Color fundus image; 45° FOV; image size 2352x1568 — 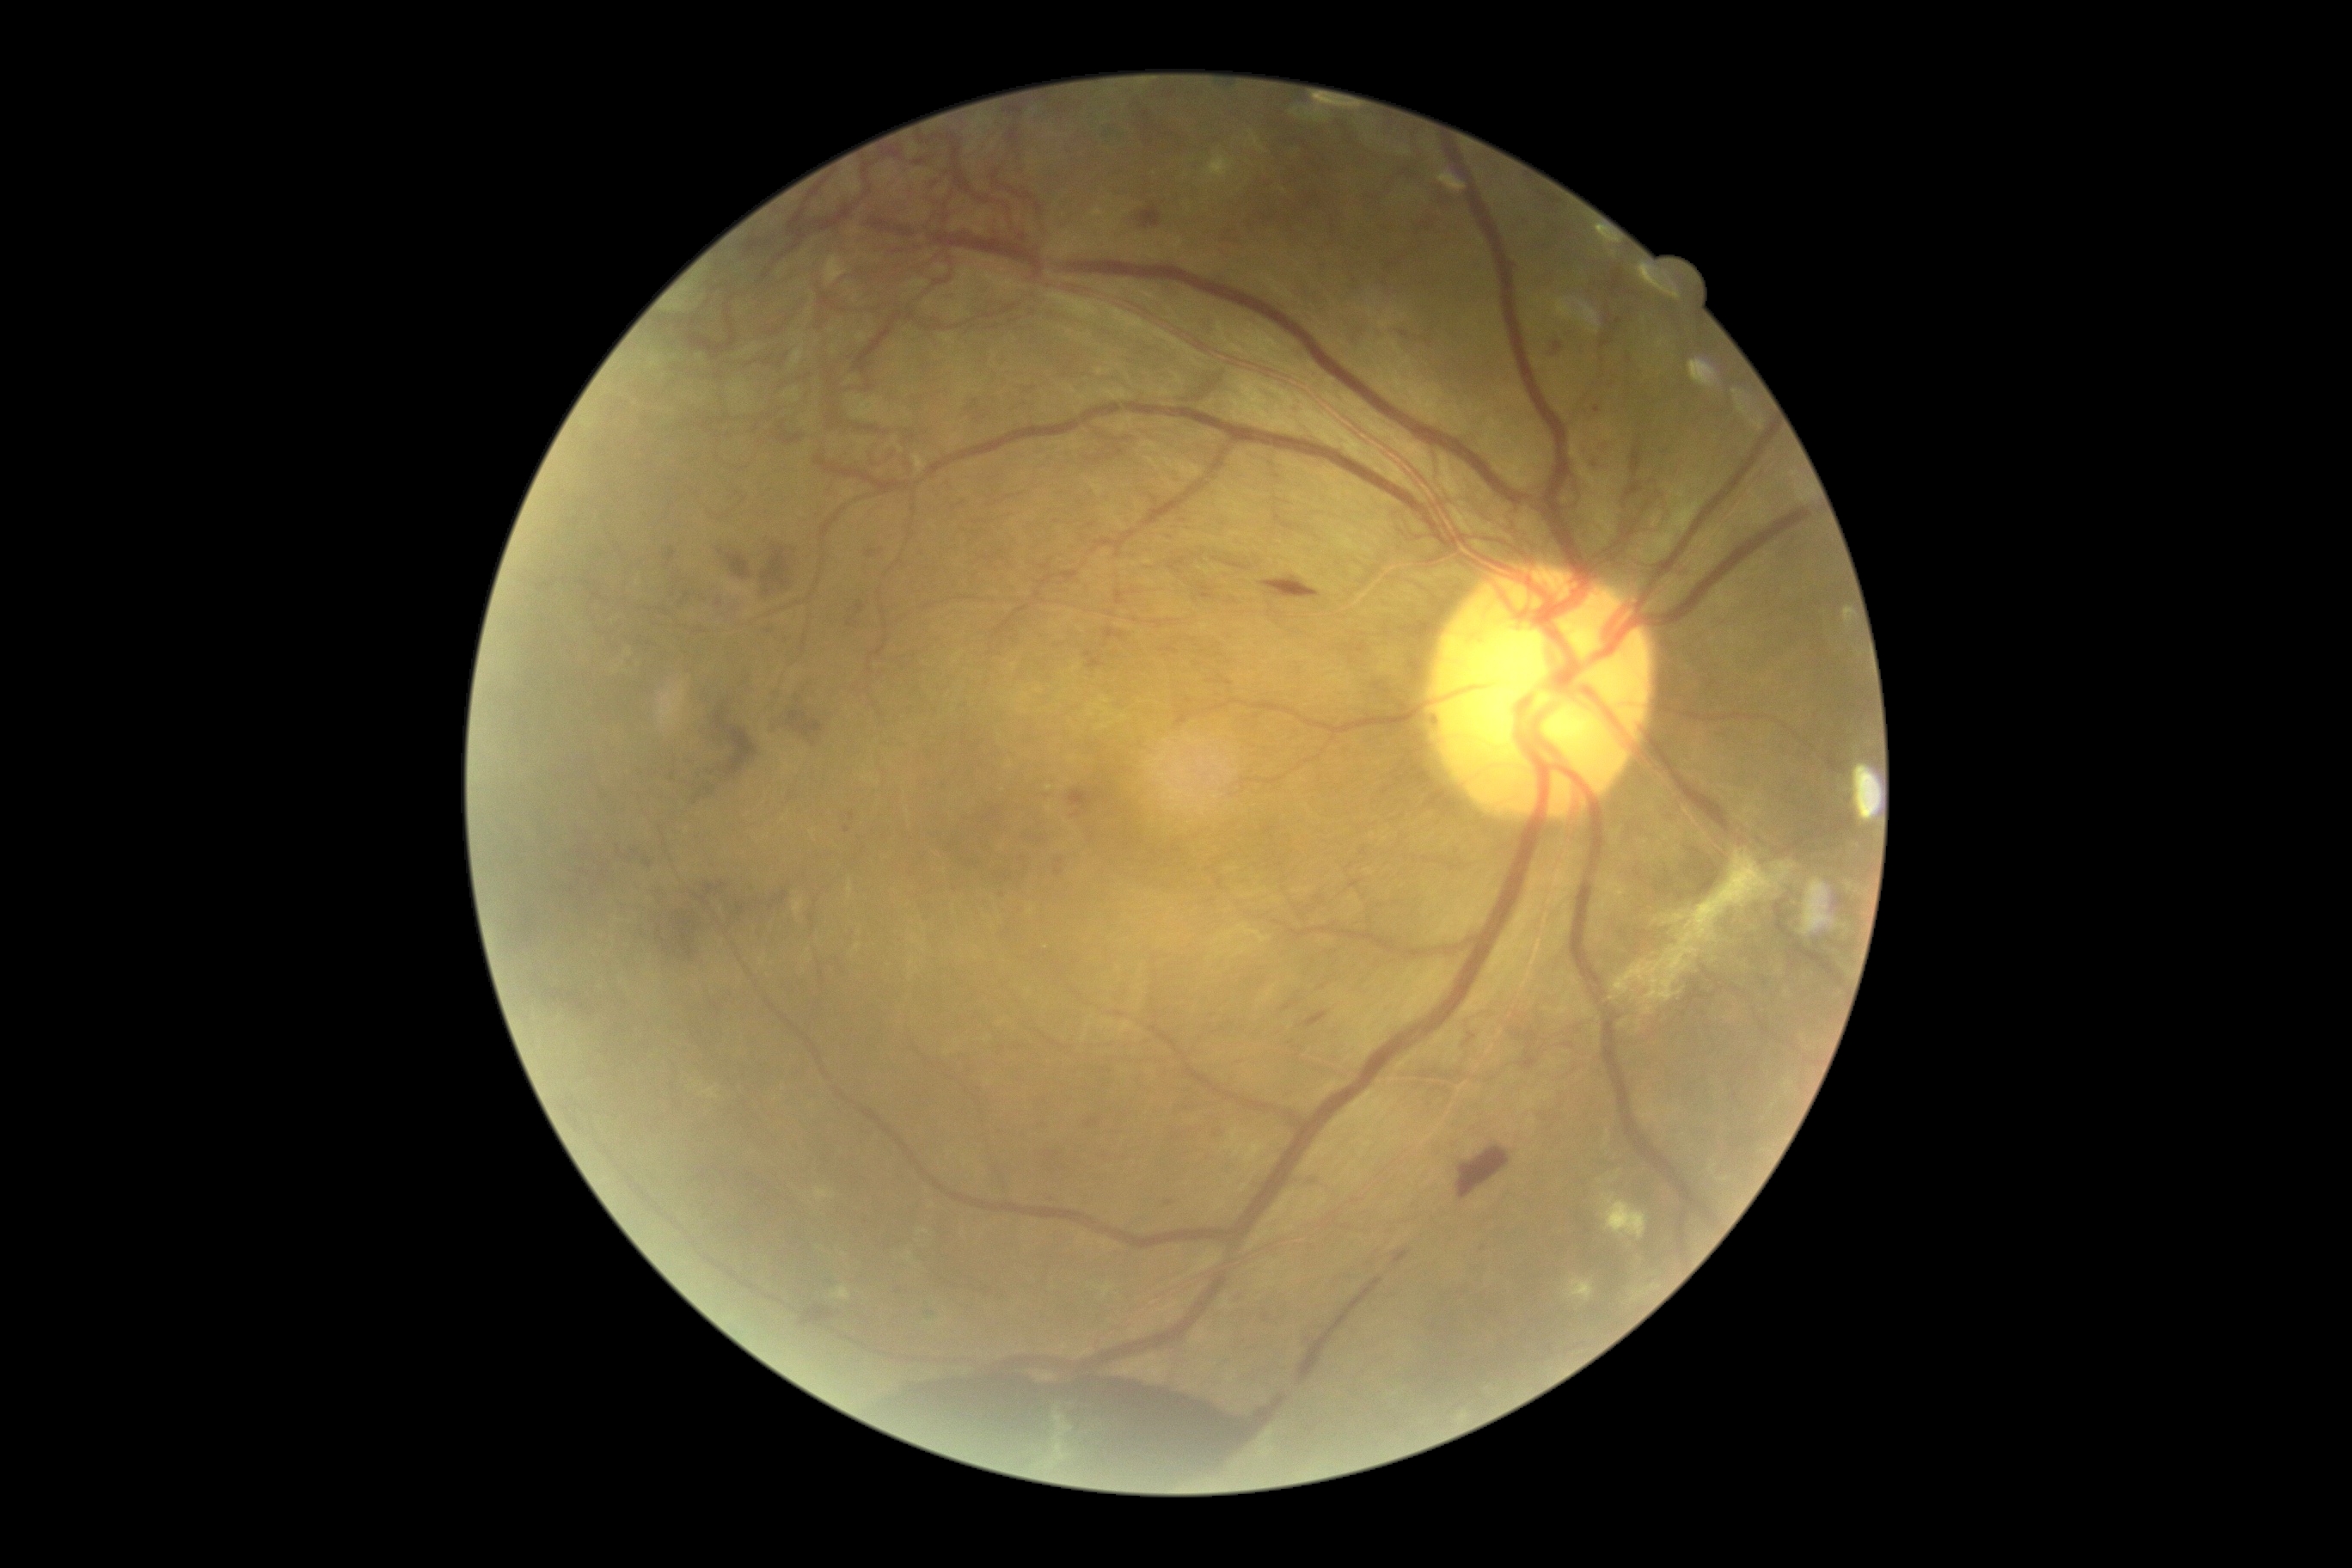 DR grade is 4 (PDR) — neovascularization and/or vitreous/pre-retinal hemorrhage
Lesions identified (partial list):
HEs (subset): (x1=1533, y1=188, x2=1571, y2=212) | (x1=1393, y1=1251, x2=1411, y2=1265) | (x1=893, y1=1283, x2=914, y2=1297) | (x1=1586, y1=438, x2=1617, y2=475) | (x1=943, y1=290, x2=957, y2=302) | (x1=1168, y1=558, x2=1185, y2=570) | (x1=1069, y1=790, x2=1093, y2=809) | (x1=1206, y1=1122, x2=1232, y2=1146) | (x1=1457, y1=1146, x2=1510, y2=1201) | (x1=1400, y1=333, x2=1409, y2=338) | (x1=1201, y1=585, x2=1216, y2=599) | (x1=714, y1=544, x2=756, y2=584) | (x1=1055, y1=867, x2=1063, y2=878) | (x1=682, y1=683, x2=764, y2=809)
HEs (small, approximate centers) near x=620, y=852 | x=1089, y=654 | x=1628, y=359 | x=716, y=1006